NIDEK AFC-230 fundus camera: 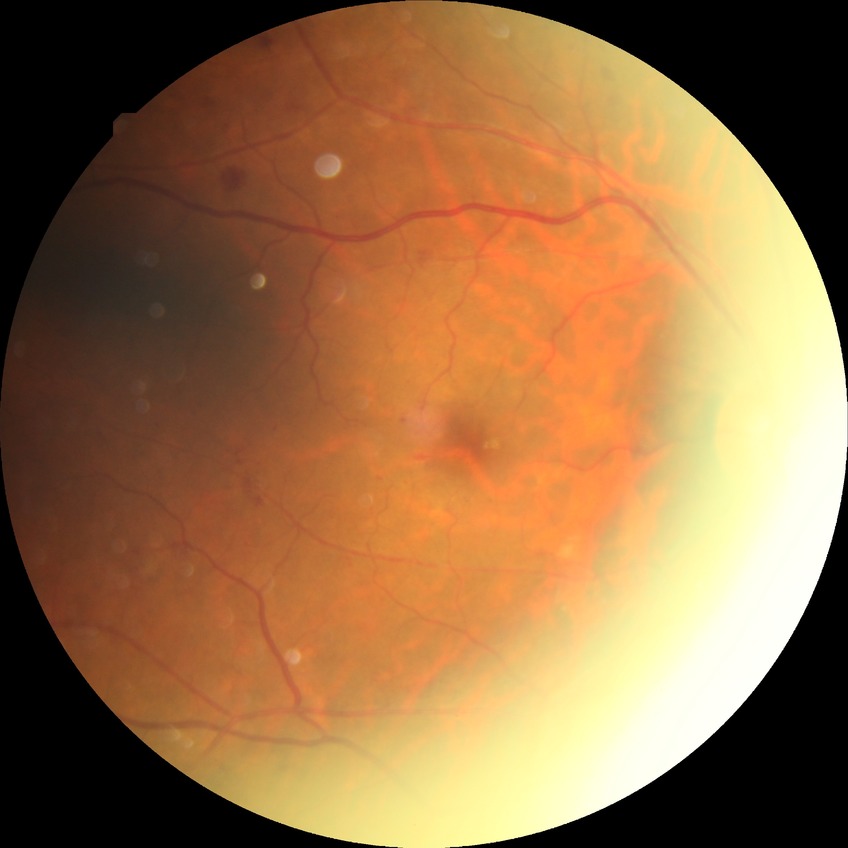 Diabetic retinopathy (DR) is PDR (proliferative diabetic retinopathy).